1932 by 1916 pixels. FOV: 45 degrees: 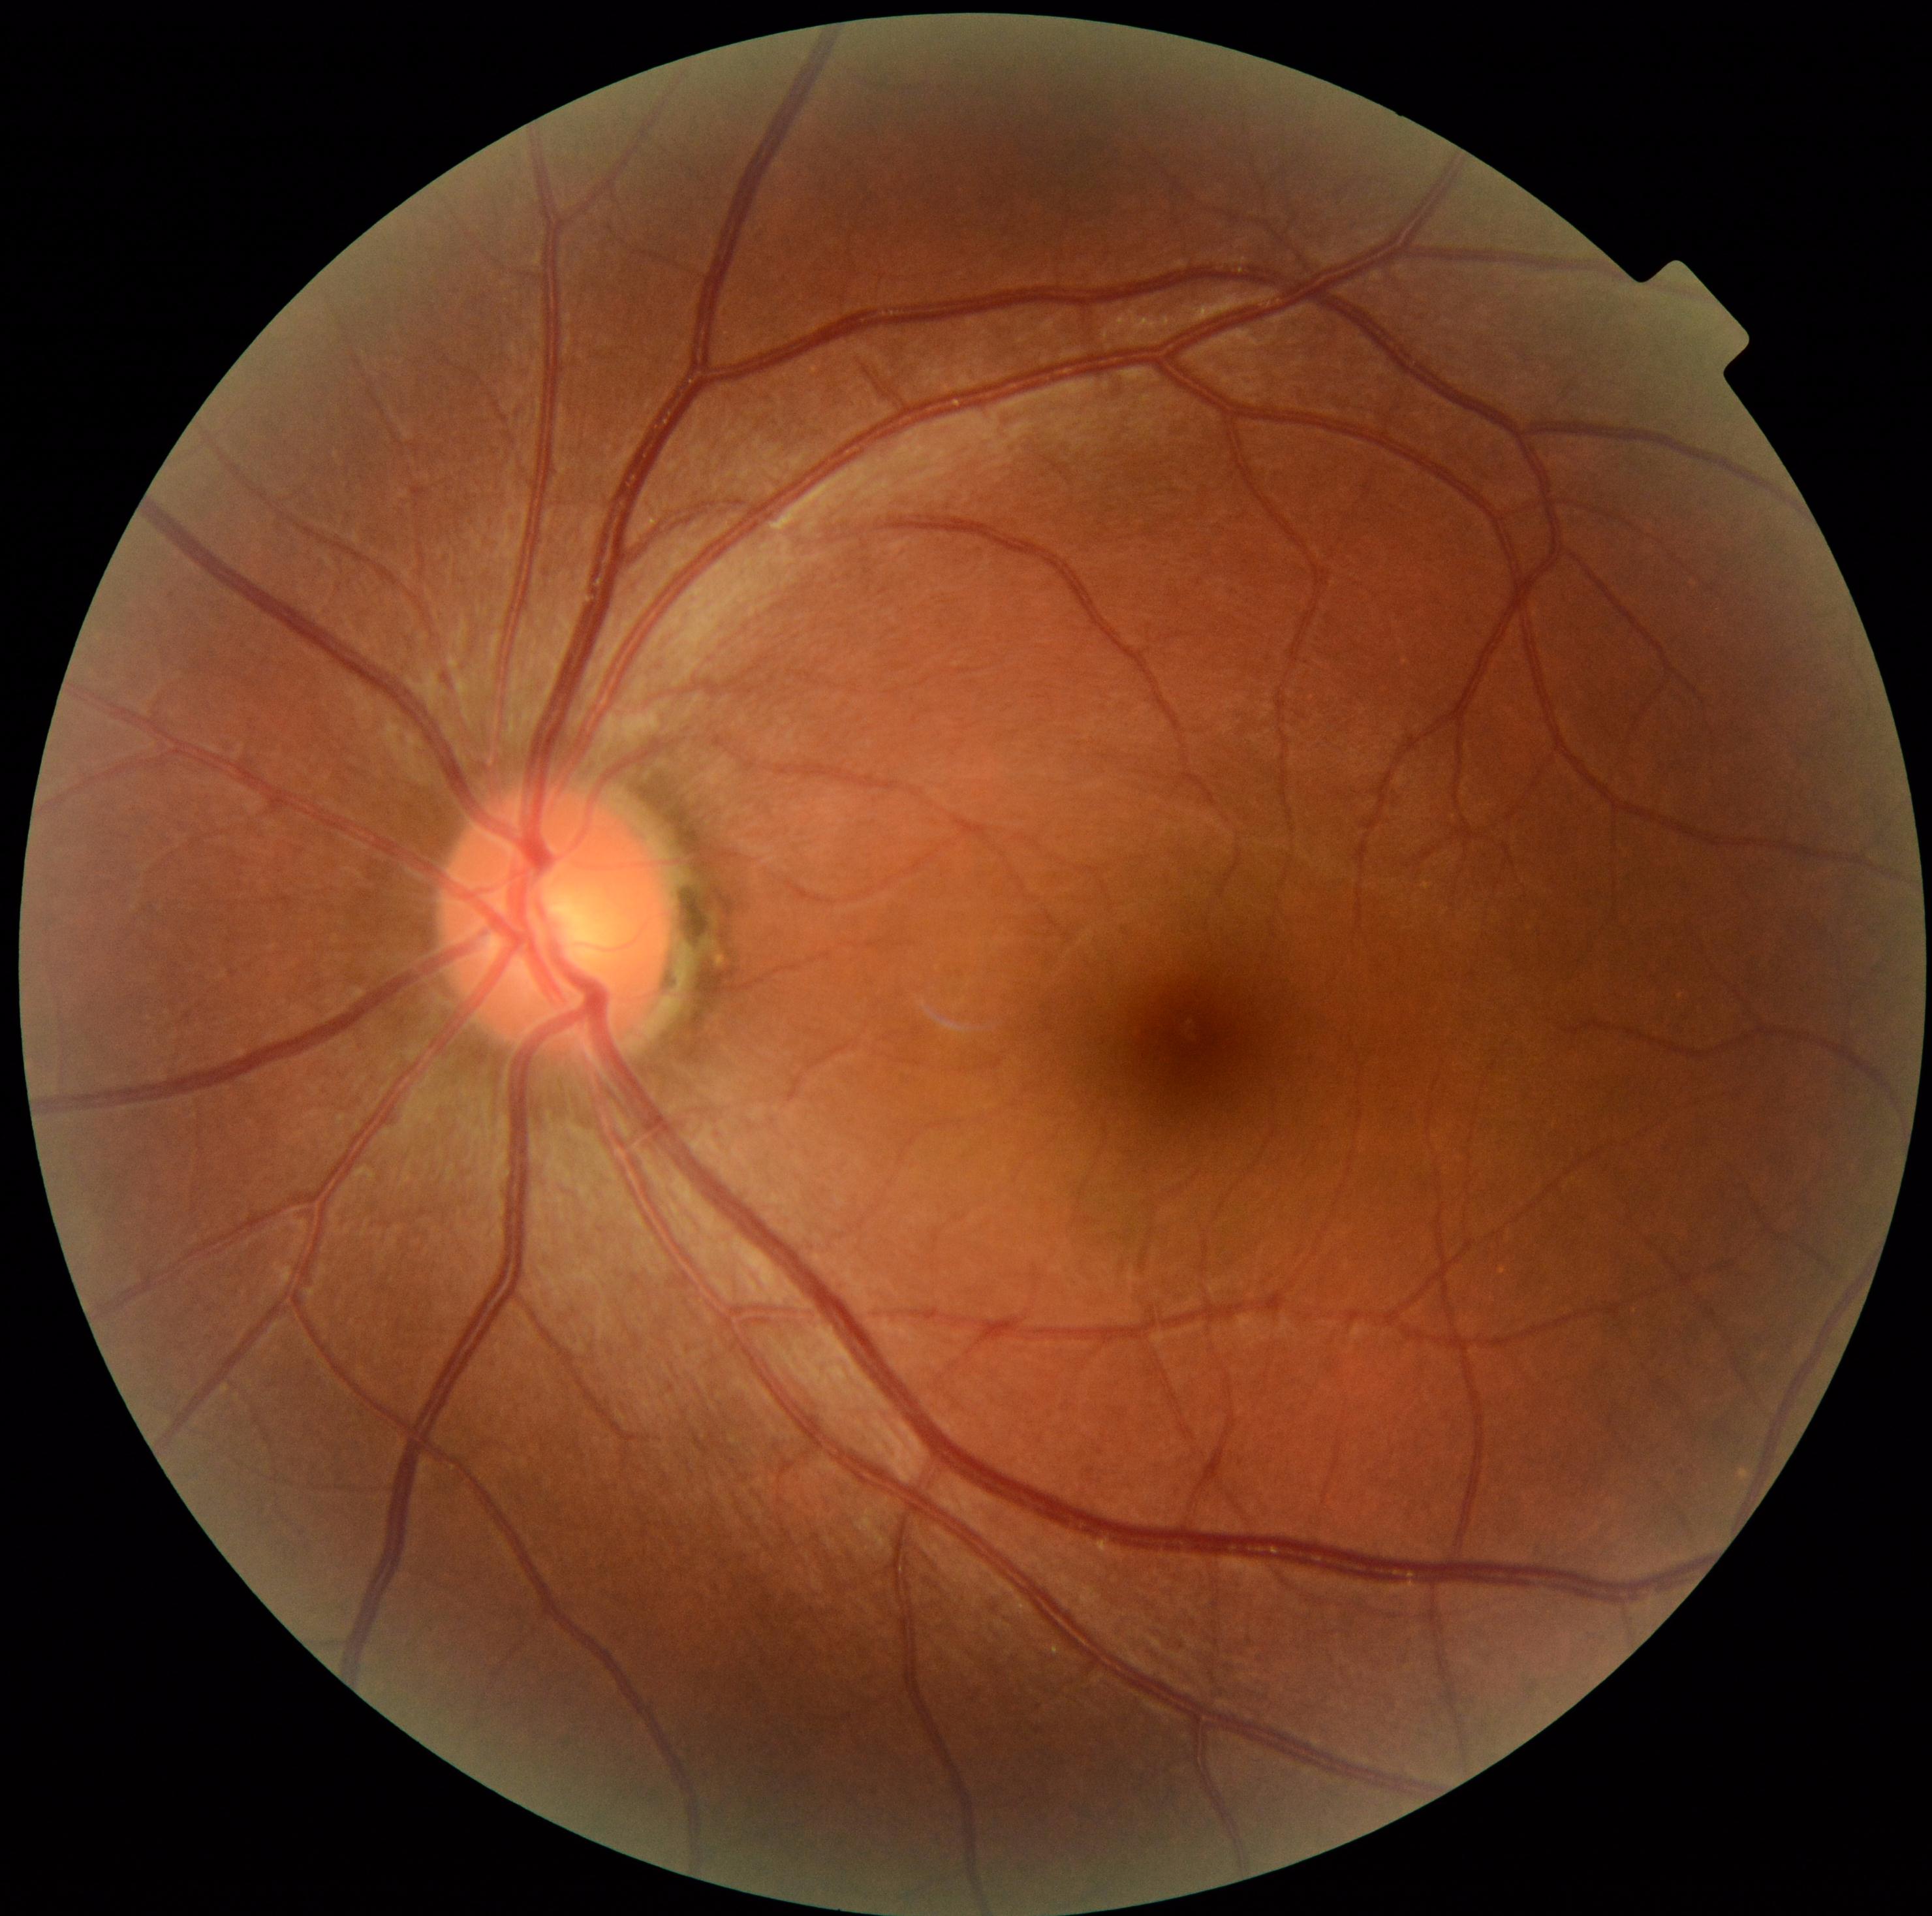

DR is no apparent retinopathy (grade 0) — no visible signs of diabetic retinopathy.